45-degree field of view:
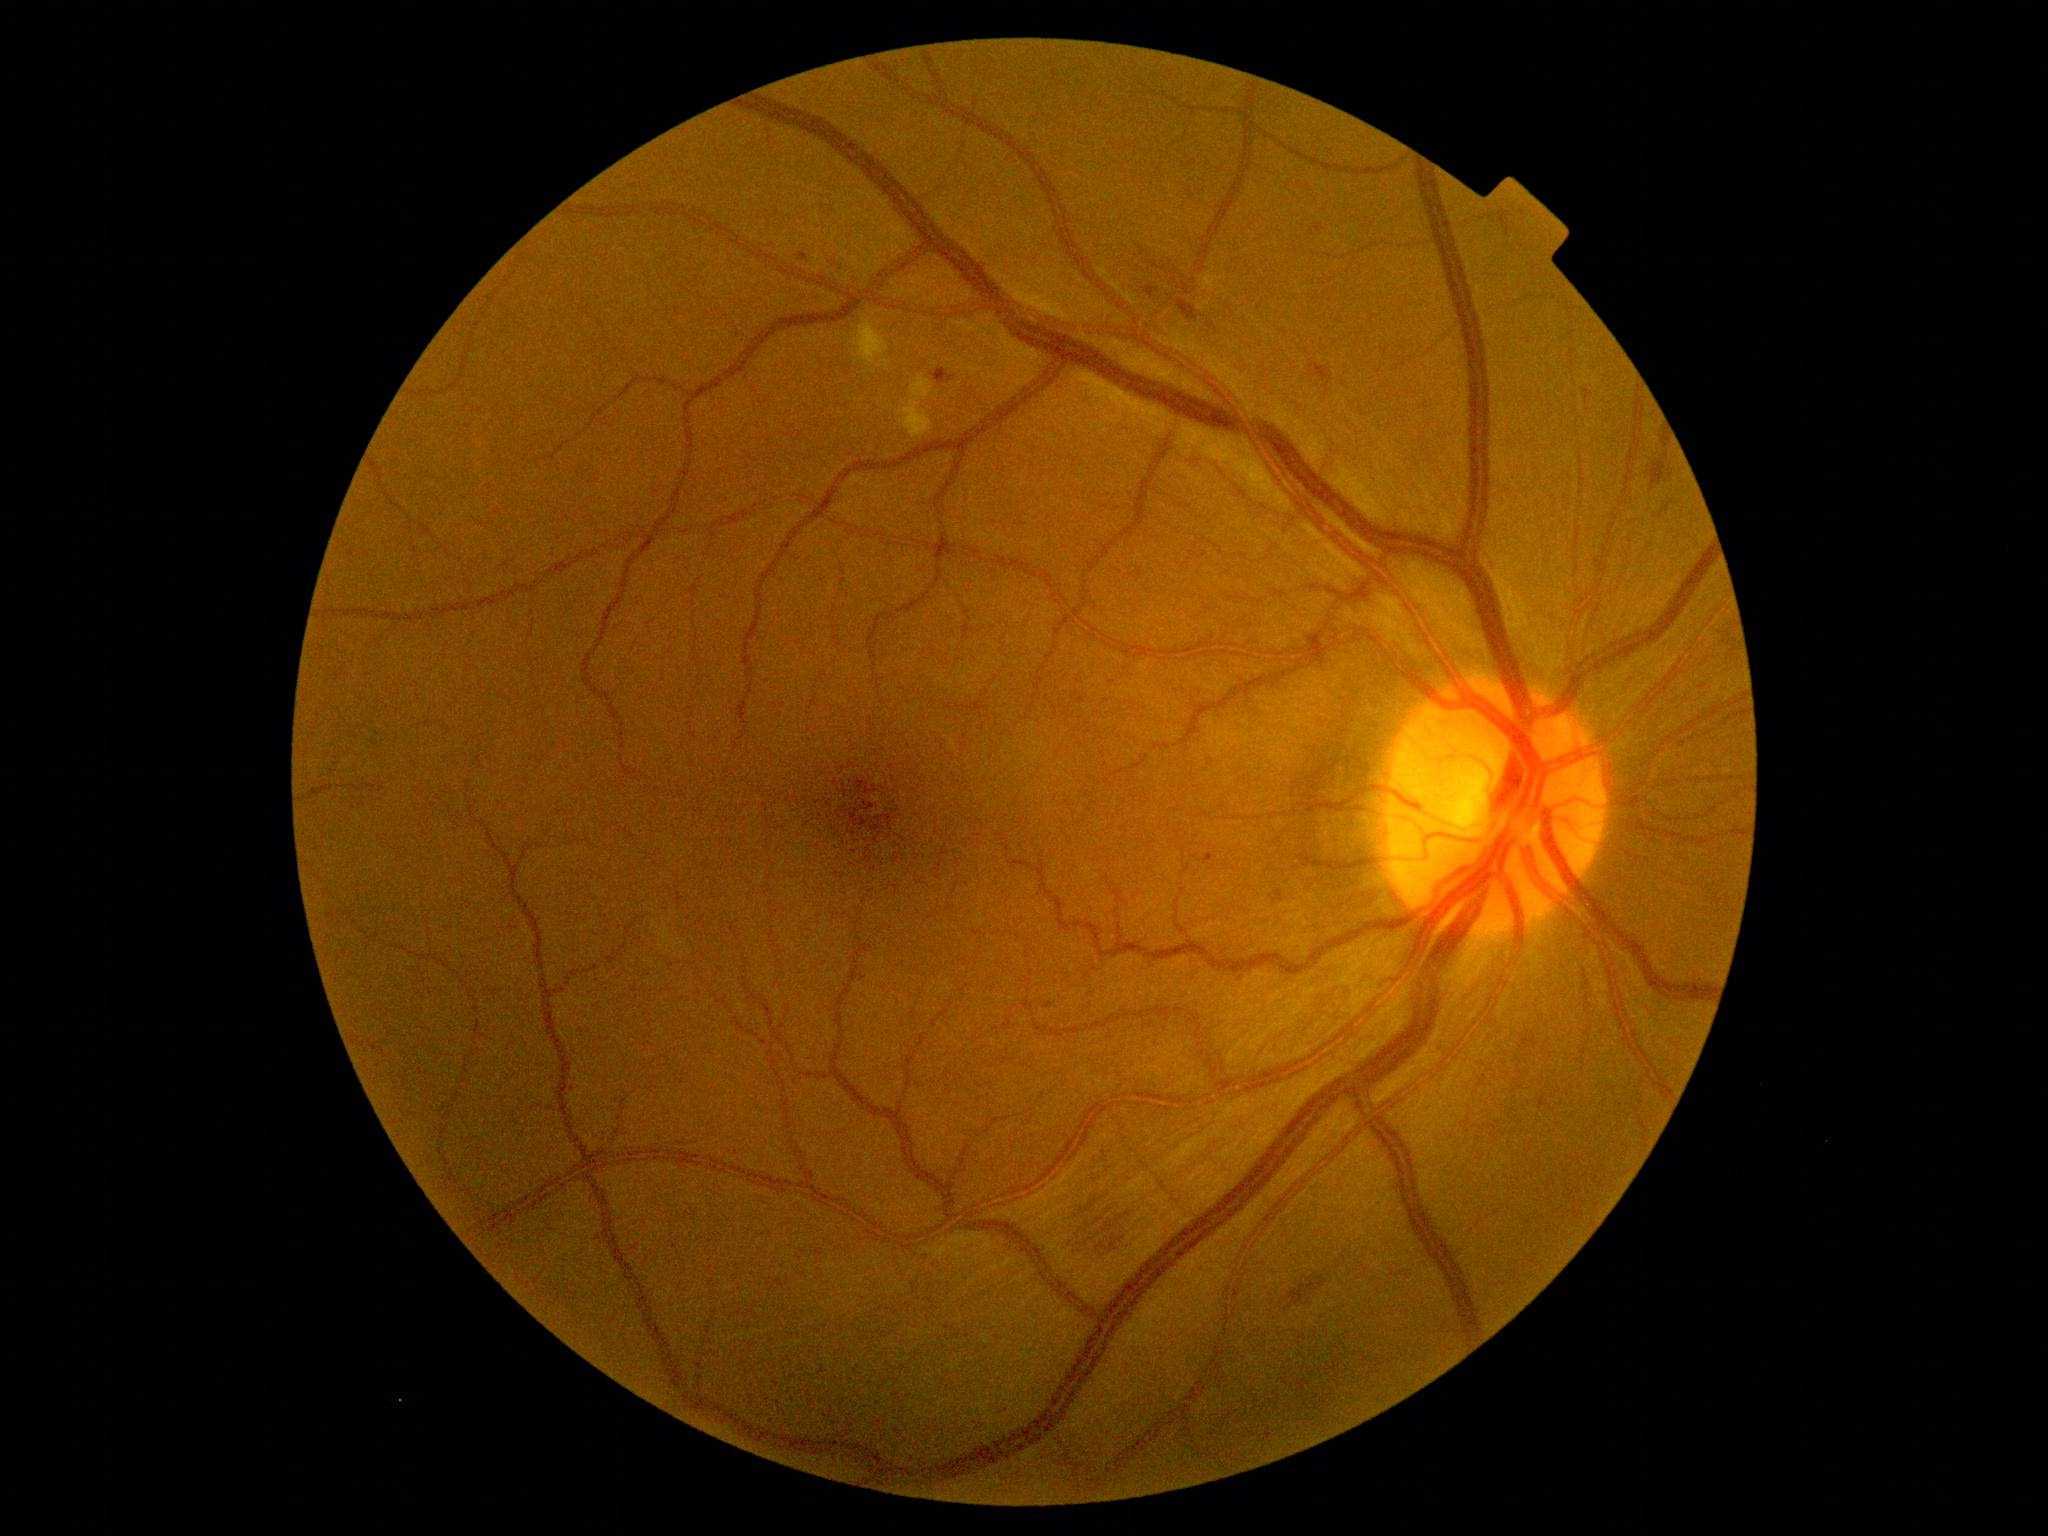 DR: 2/4
* EXs: none identified
* MAs: [left=1310, top=224, right=1325, bottom=237]; [left=1582, top=390, right=1593, bottom=400]; [left=1145, top=287, right=1159, bottom=299]; [left=931, top=369, right=955, bottom=386]; [left=796, top=253, right=809, bottom=263]; [left=1046, top=1002, right=1054, bottom=1010]; [left=1203, top=854, right=1216, bottom=864]
* HEs: [left=1076, top=1192, right=1132, bottom=1263]; [left=1307, top=360, right=1334, bottom=396]; [left=1647, top=428, right=1672, bottom=491]; [left=1285, top=1277, right=1328, bottom=1312]; [left=1178, top=300, right=1199, bottom=322]
* SEs: [left=898, top=376, right=932, bottom=439]; [left=853, top=317, right=889, bottom=368]